FOV: 45 degrees
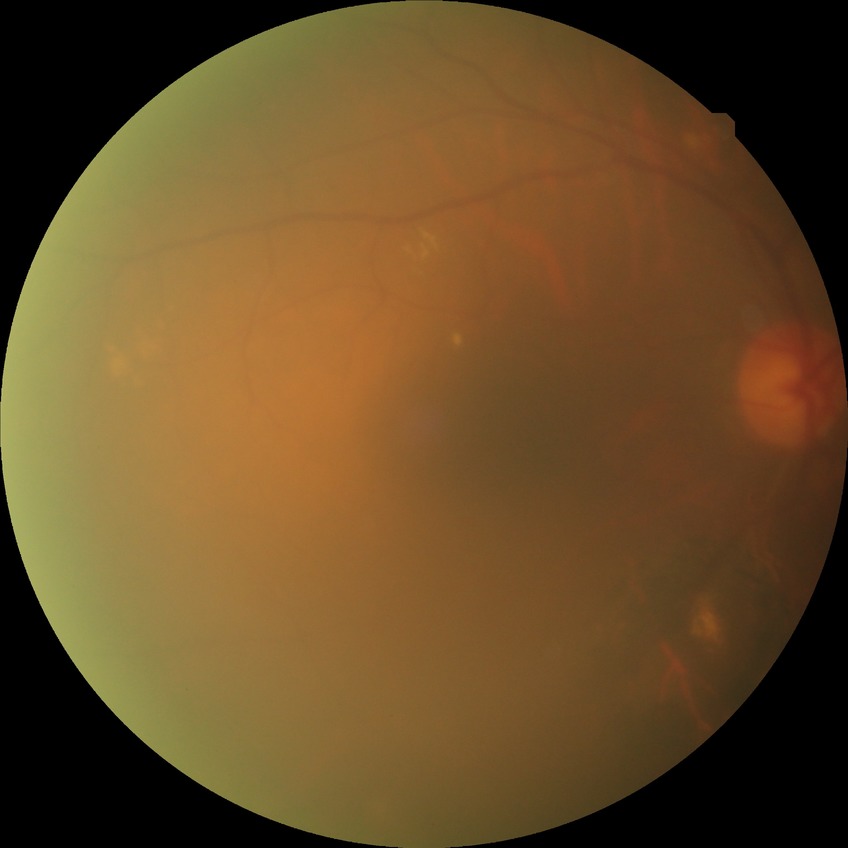

Retinopathy grade is no diabetic retinopathy.